Captured with the Phoenix ICON (100° field of view). 1240x1240px. Wide-field fundus image from infant ROP screening — 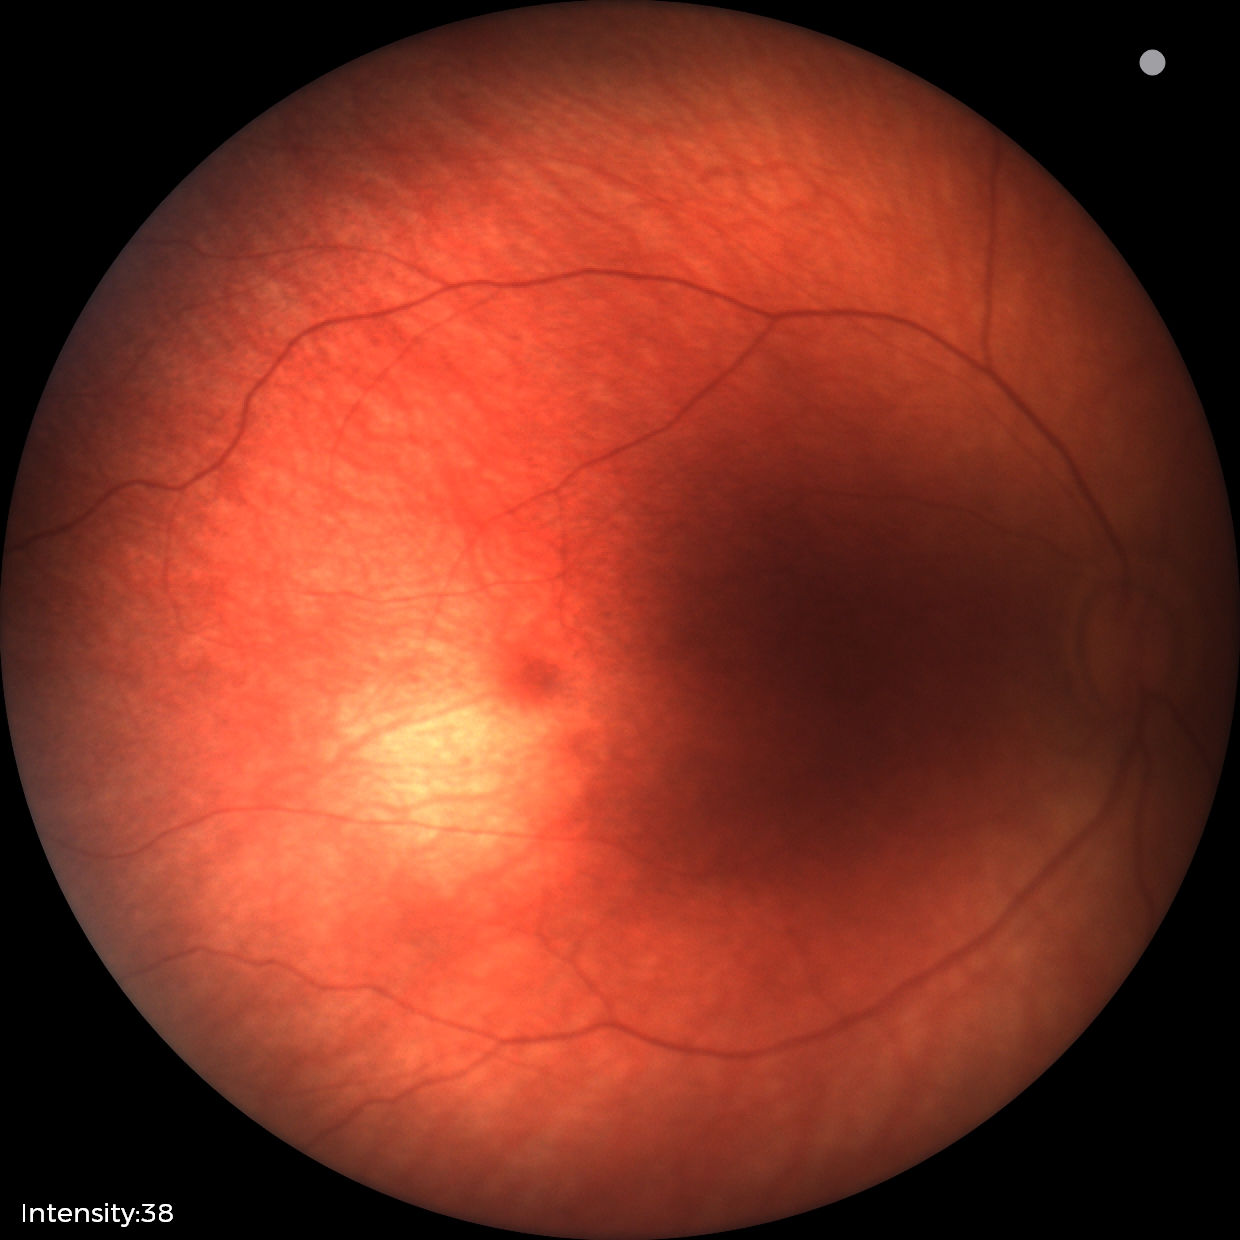
Screening: physiological finding.